Phoenix ICON, 100° FOV · infant wide-field retinal image: 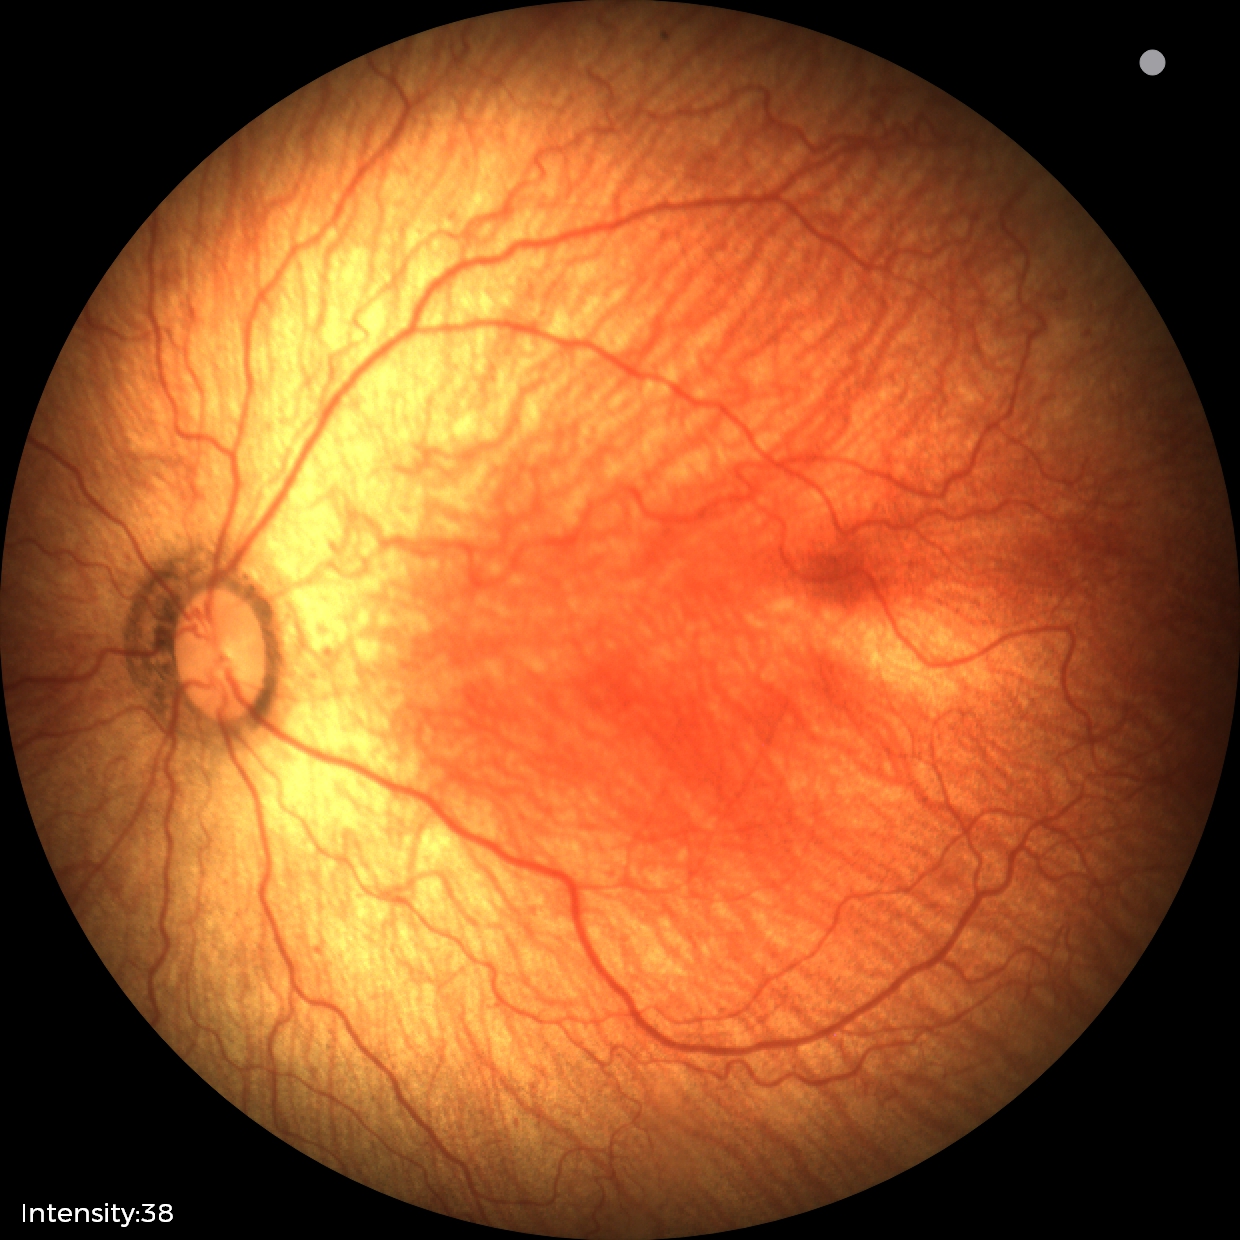 Screening diagnosis: retinopathy of prematurity stage 1, plus form: absent.